Captured on a Nidek AFC-330 fundus camera: 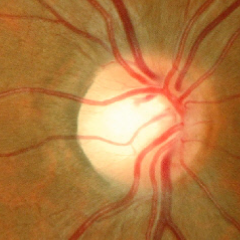 Q: Does this eye have glaucoma?
A: No — no glaucoma.